Pupil-dilated.
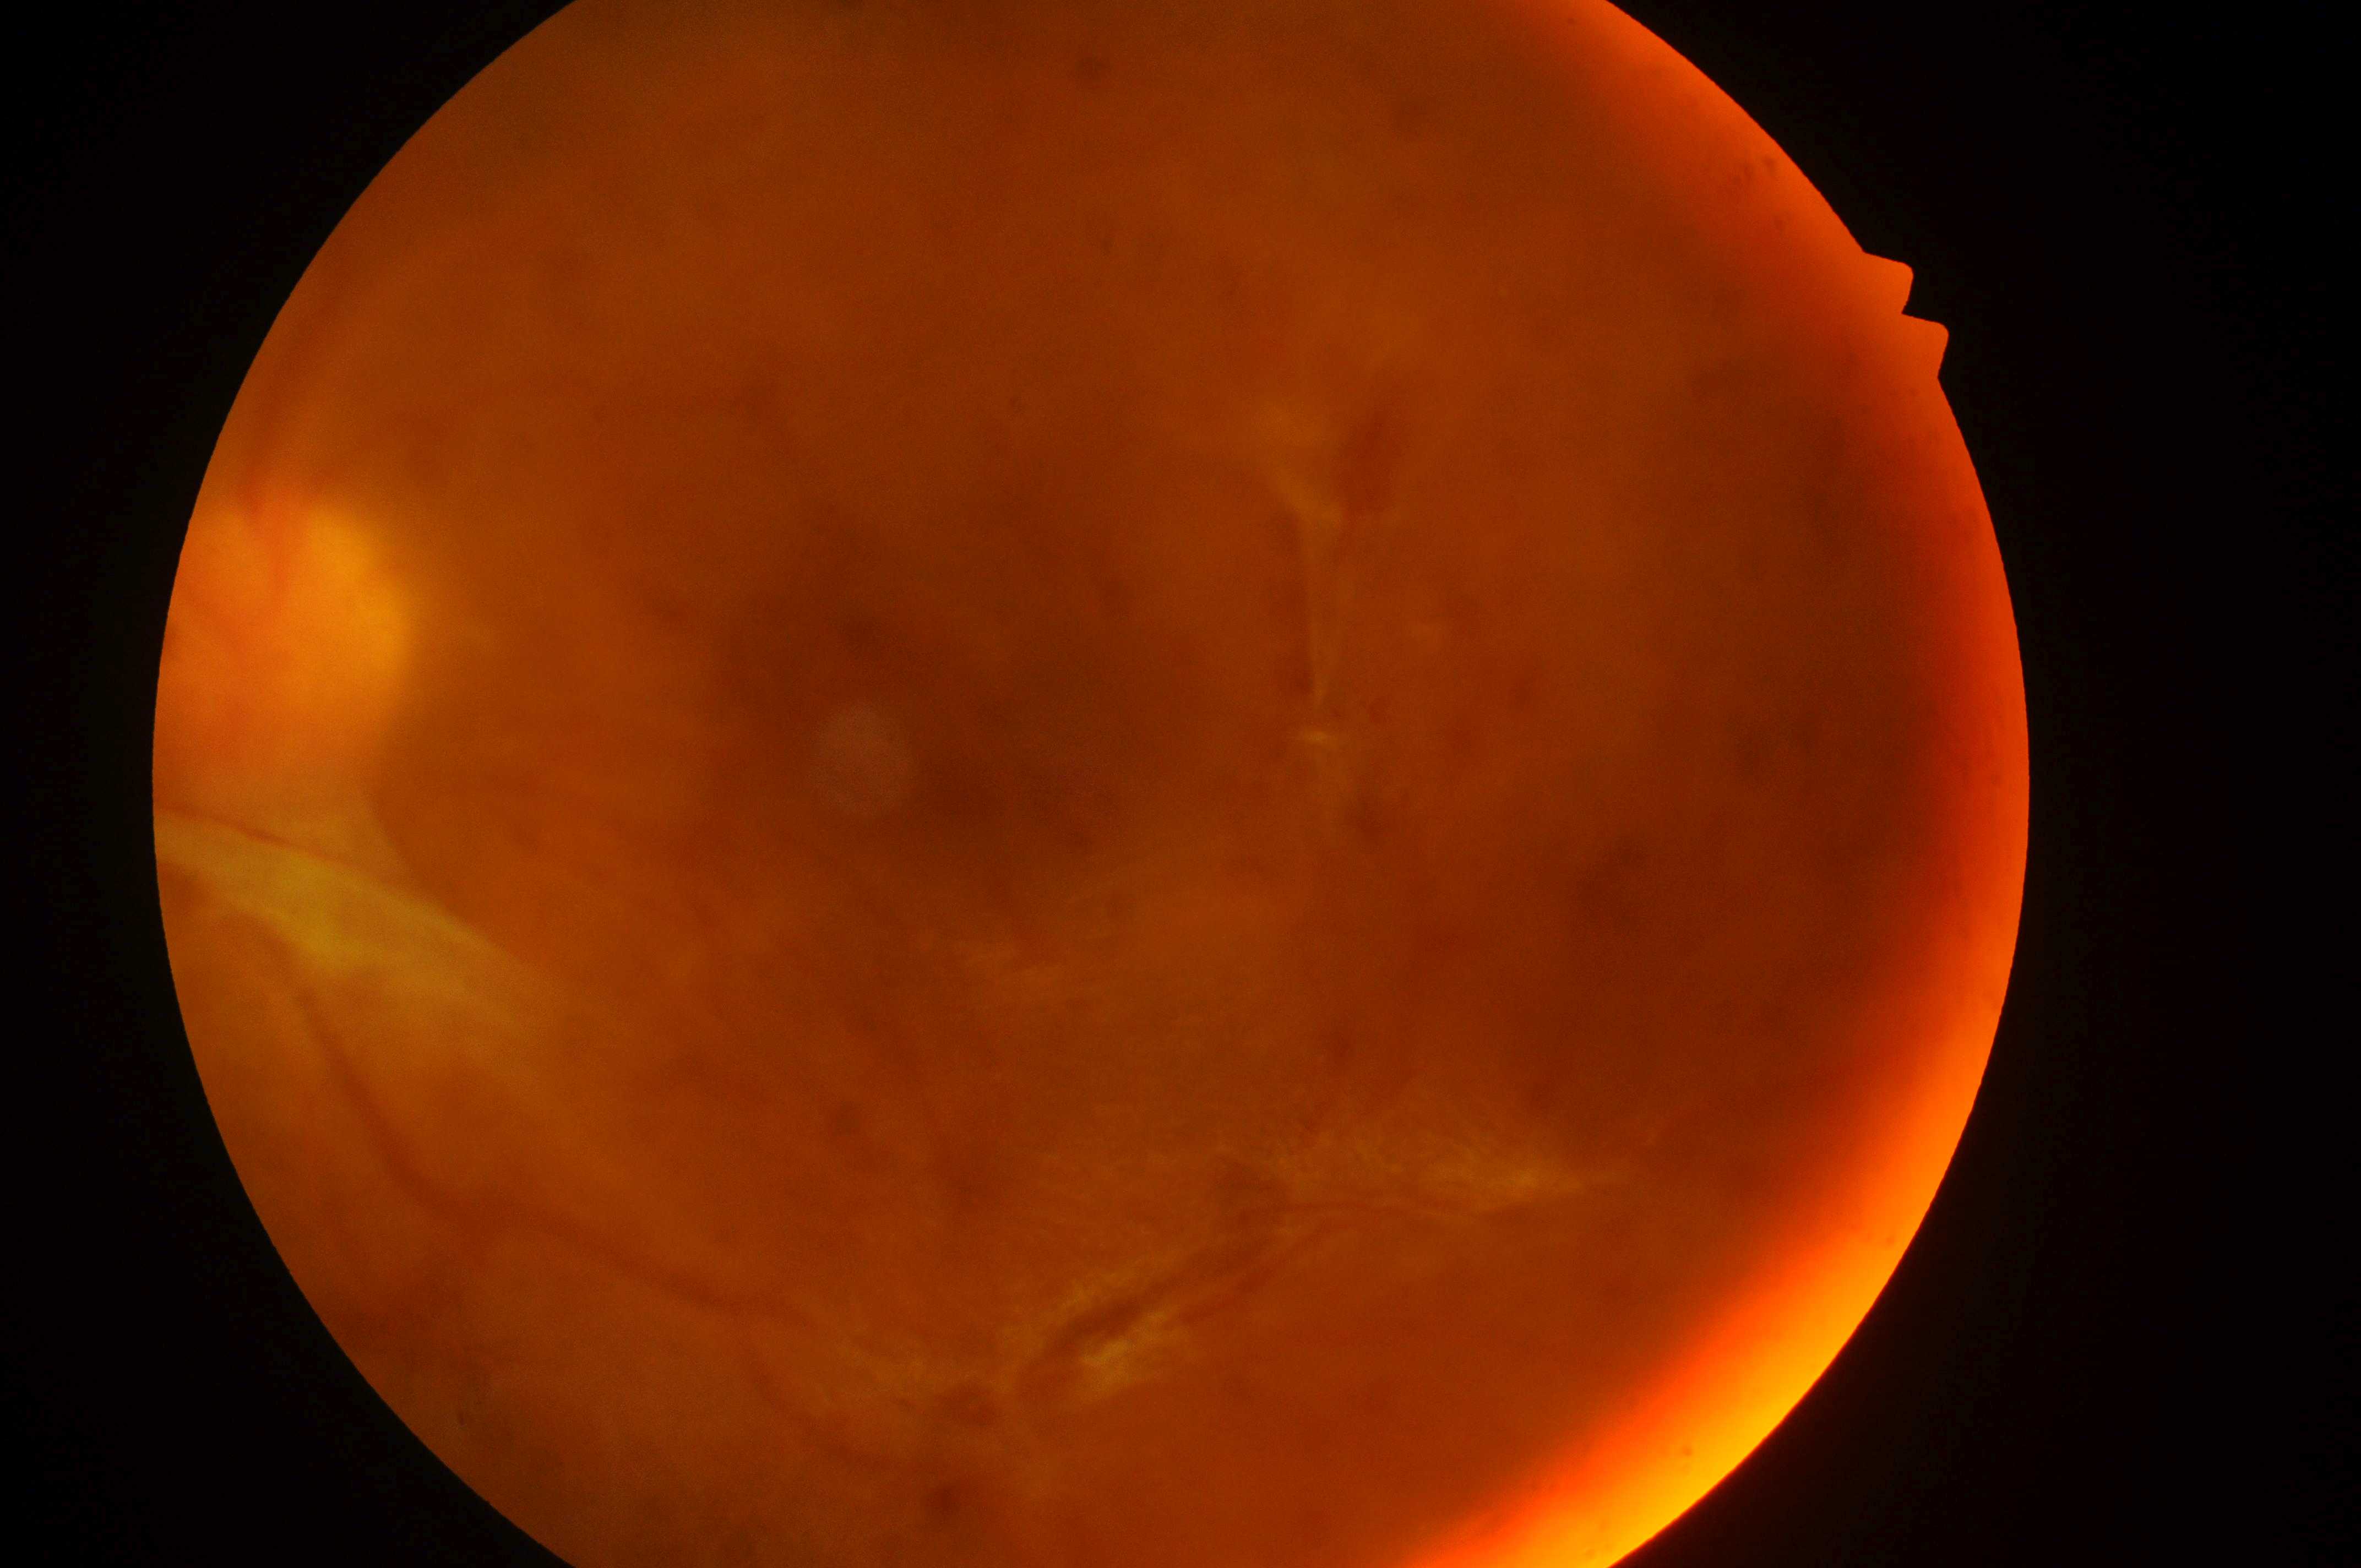

laterality = oculus sinister
diabetic macular edema = high risk (grade 2)
optic disc = (264,647)
the fovea = (1089,711)
retinopathy = PDR (grade 4)